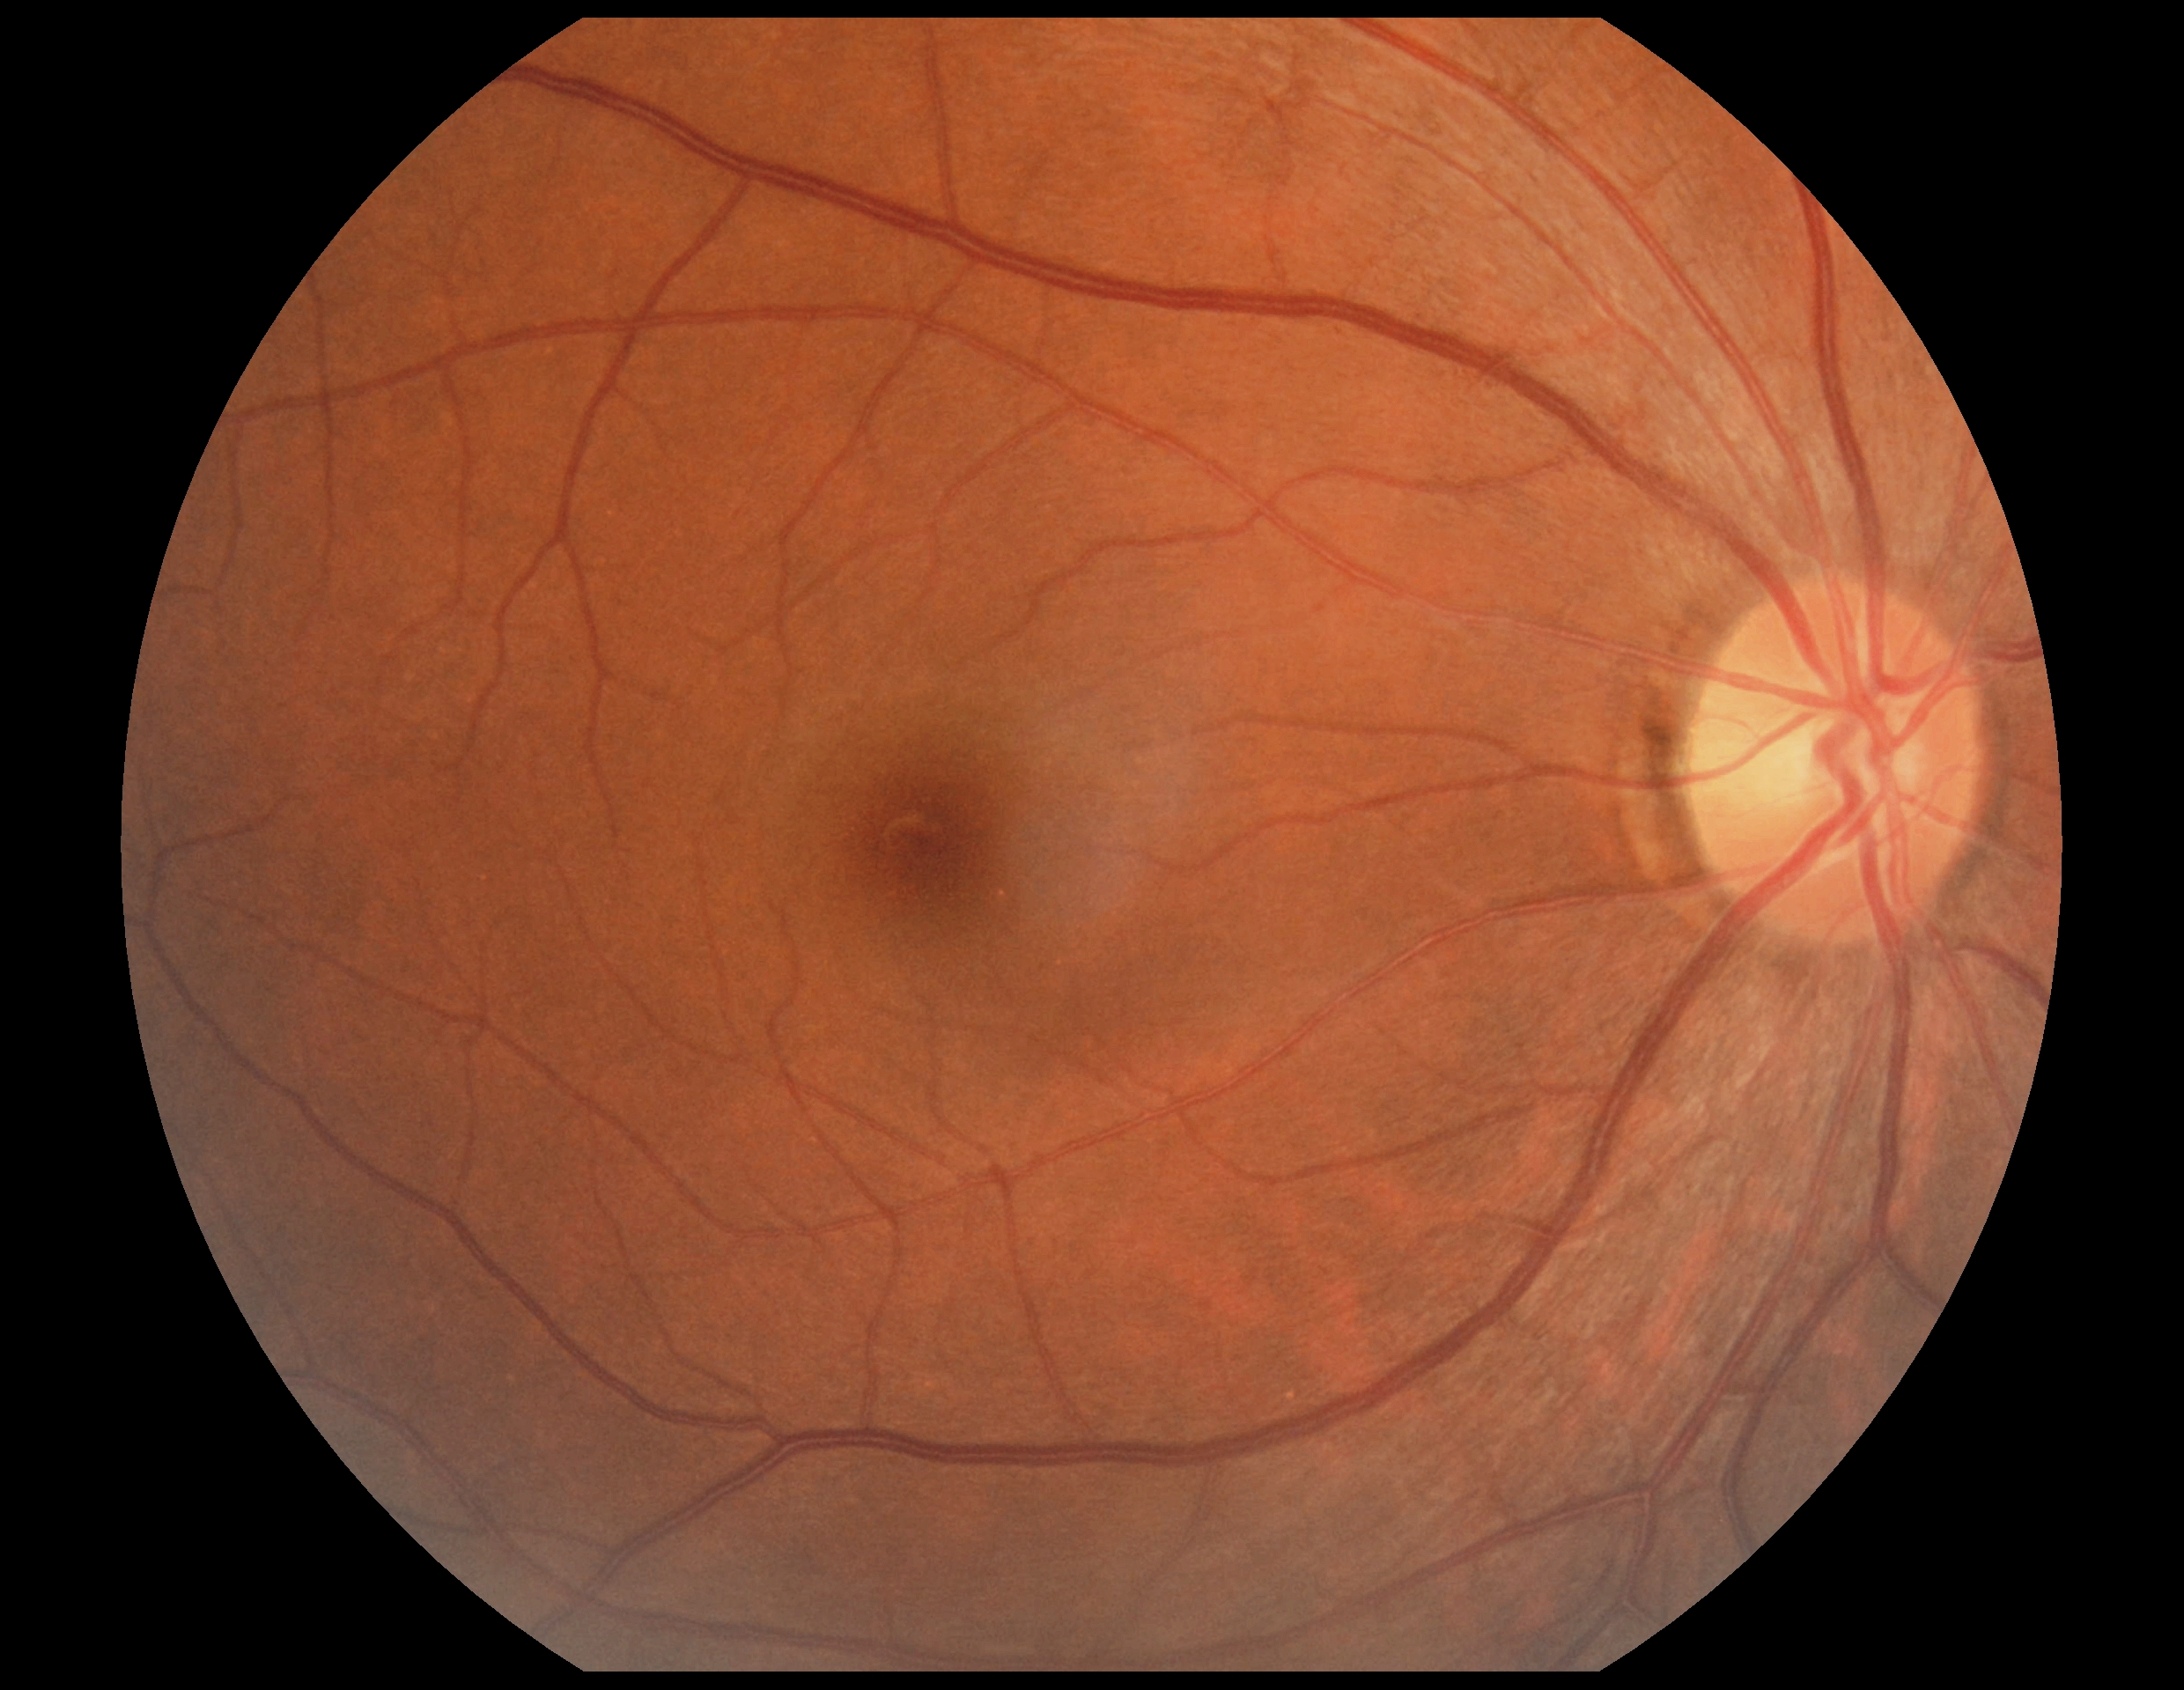

Diabetic retinopathy (DR) is 0/4.